Camera: NIDEK AFC-230 · 45 degree fundus photograph · no pharmacologic dilation
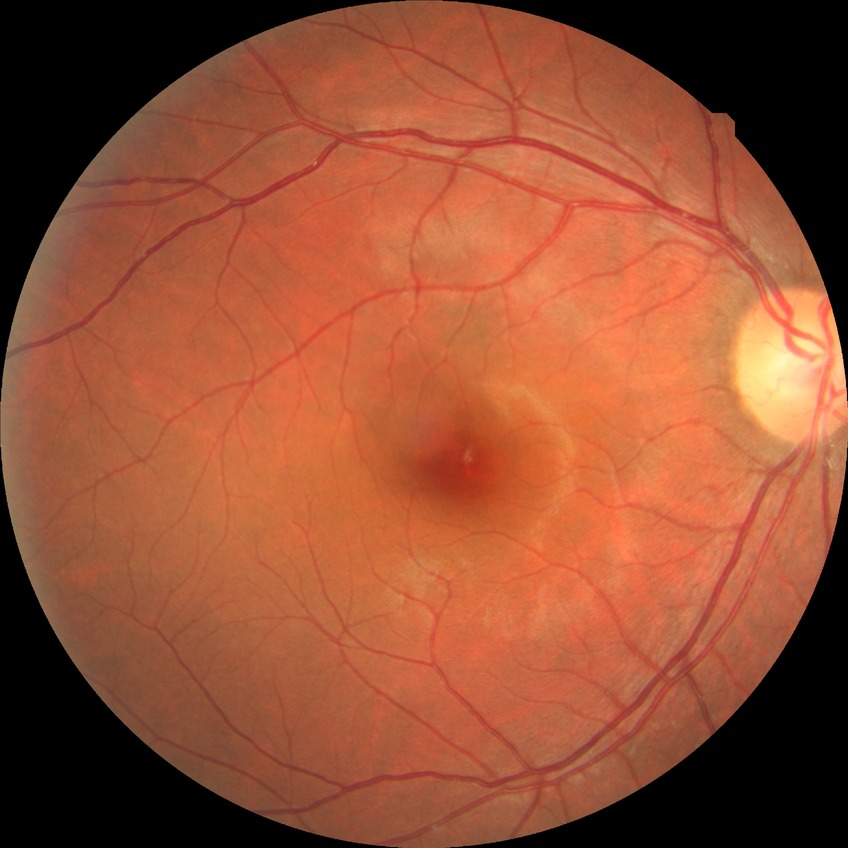

No diabetic retinal disease findings. DR severity: NDR.